Acquired with a NIDEK AFC-230: 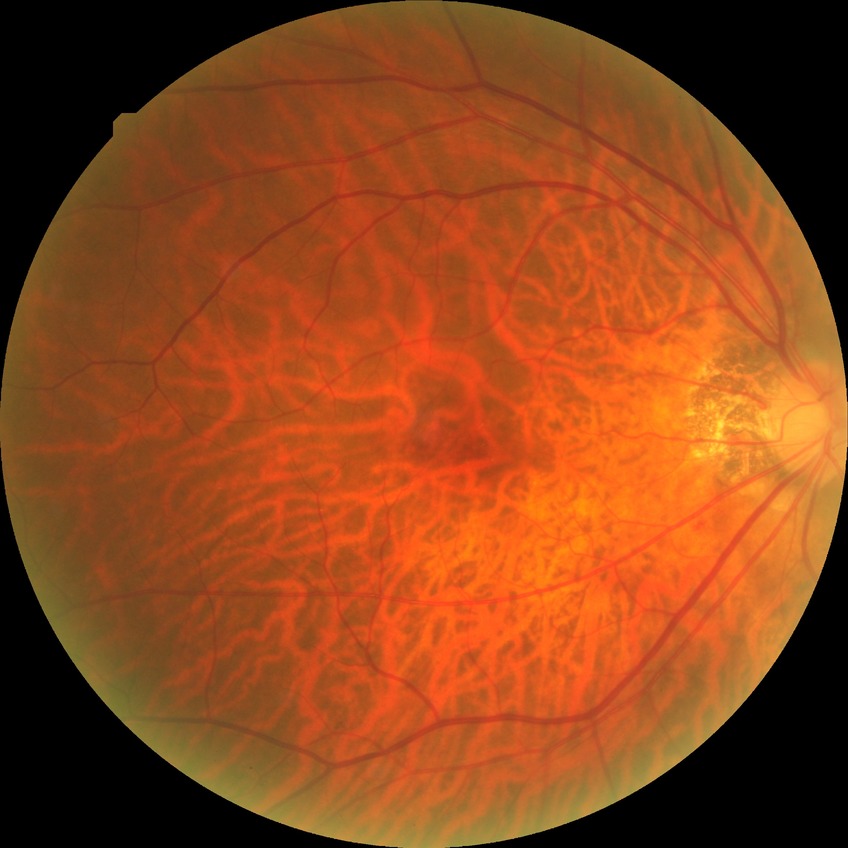

Diabetic retinopathy stage: no diabetic retinopathy.